No pharmacologic dilation; 848 by 848 pixels; retinal fundus photograph; 45-degree field of view; diabetic retinopathy graded by the modified Davis classification; acquired with a NIDEK AFC-230.
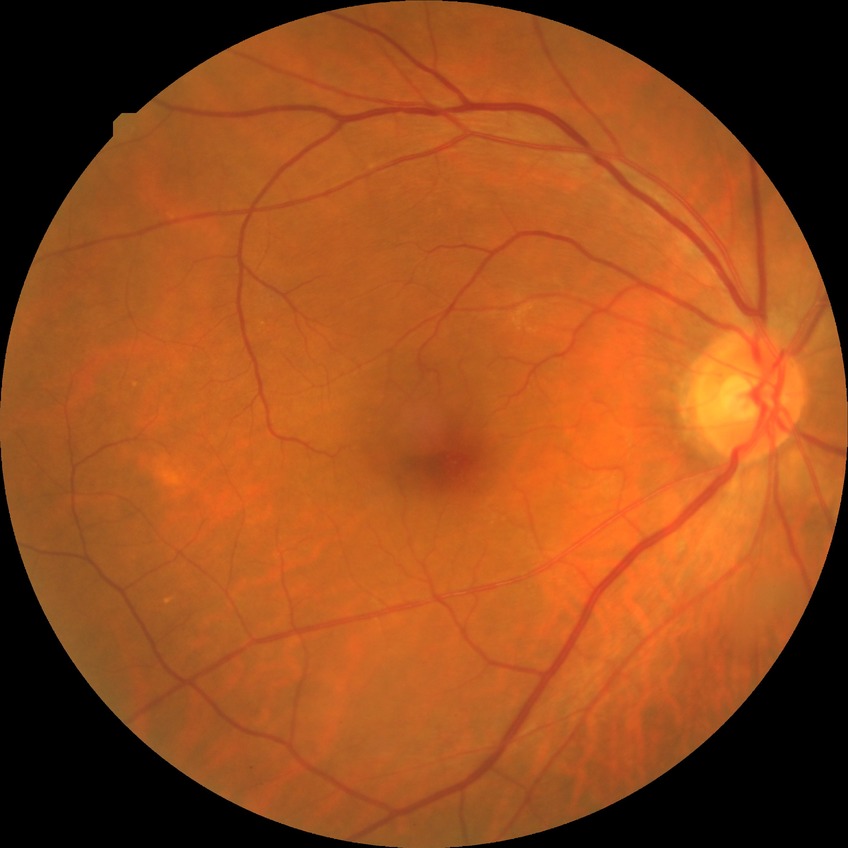 Findings:
– DR severity: NDR